Wide-field fundus image from infant ROP screening · 1240x1240px · captured with the Phoenix ICON (100° field of view)
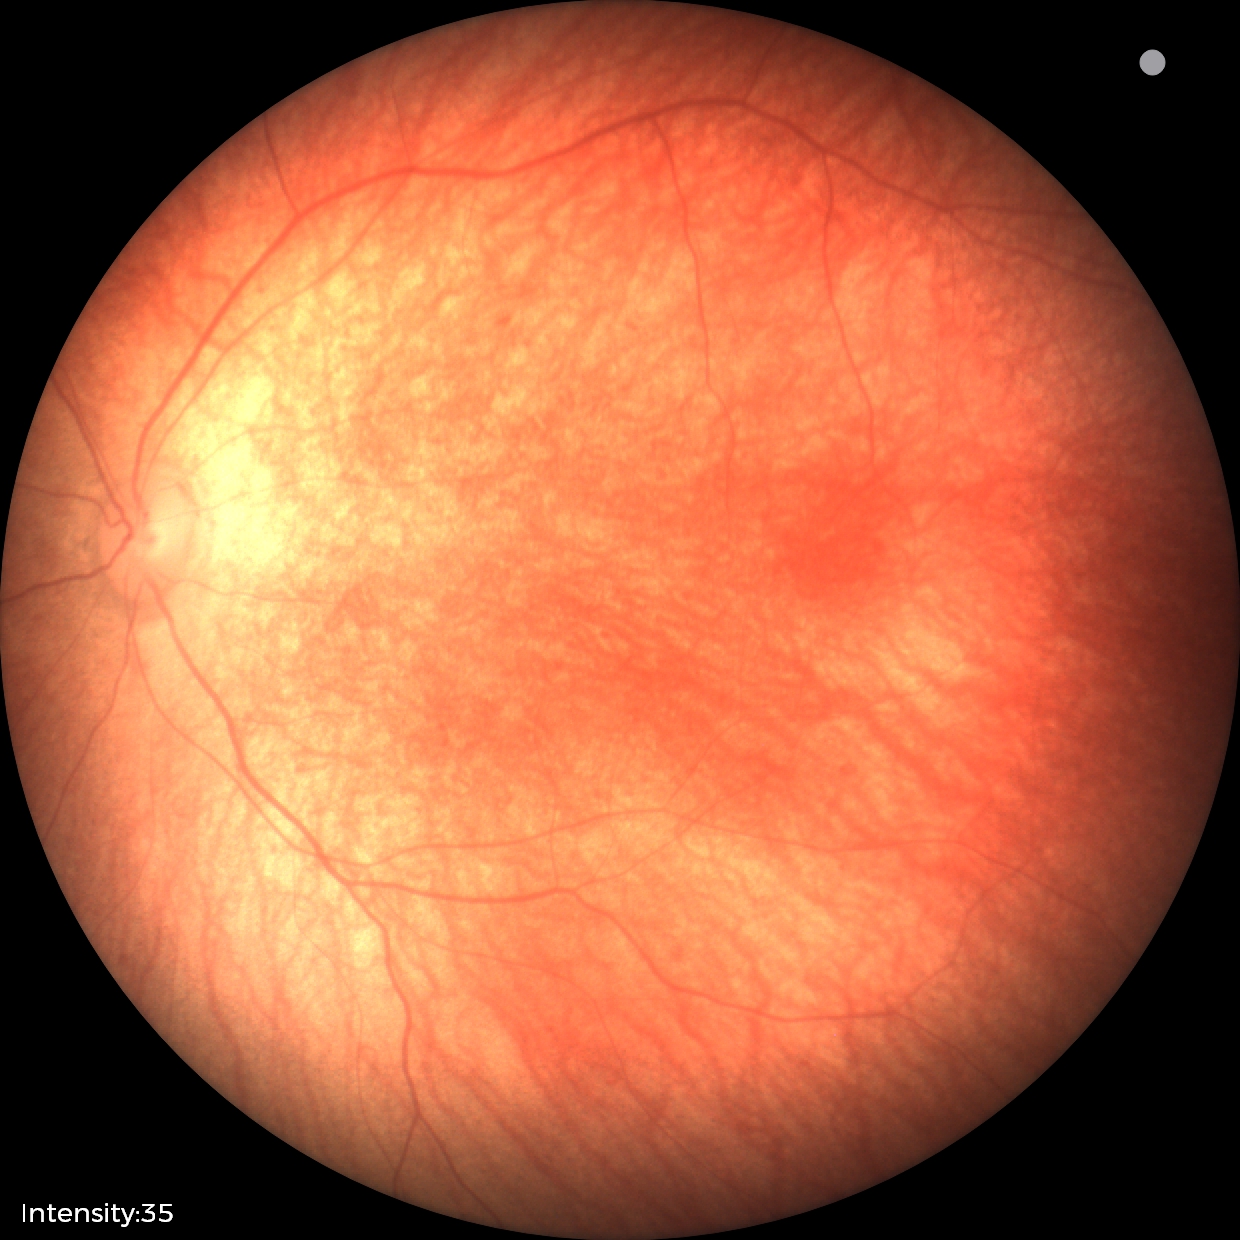
Impression: normal retinal appearance.